Camera: Kowa VX-10α — 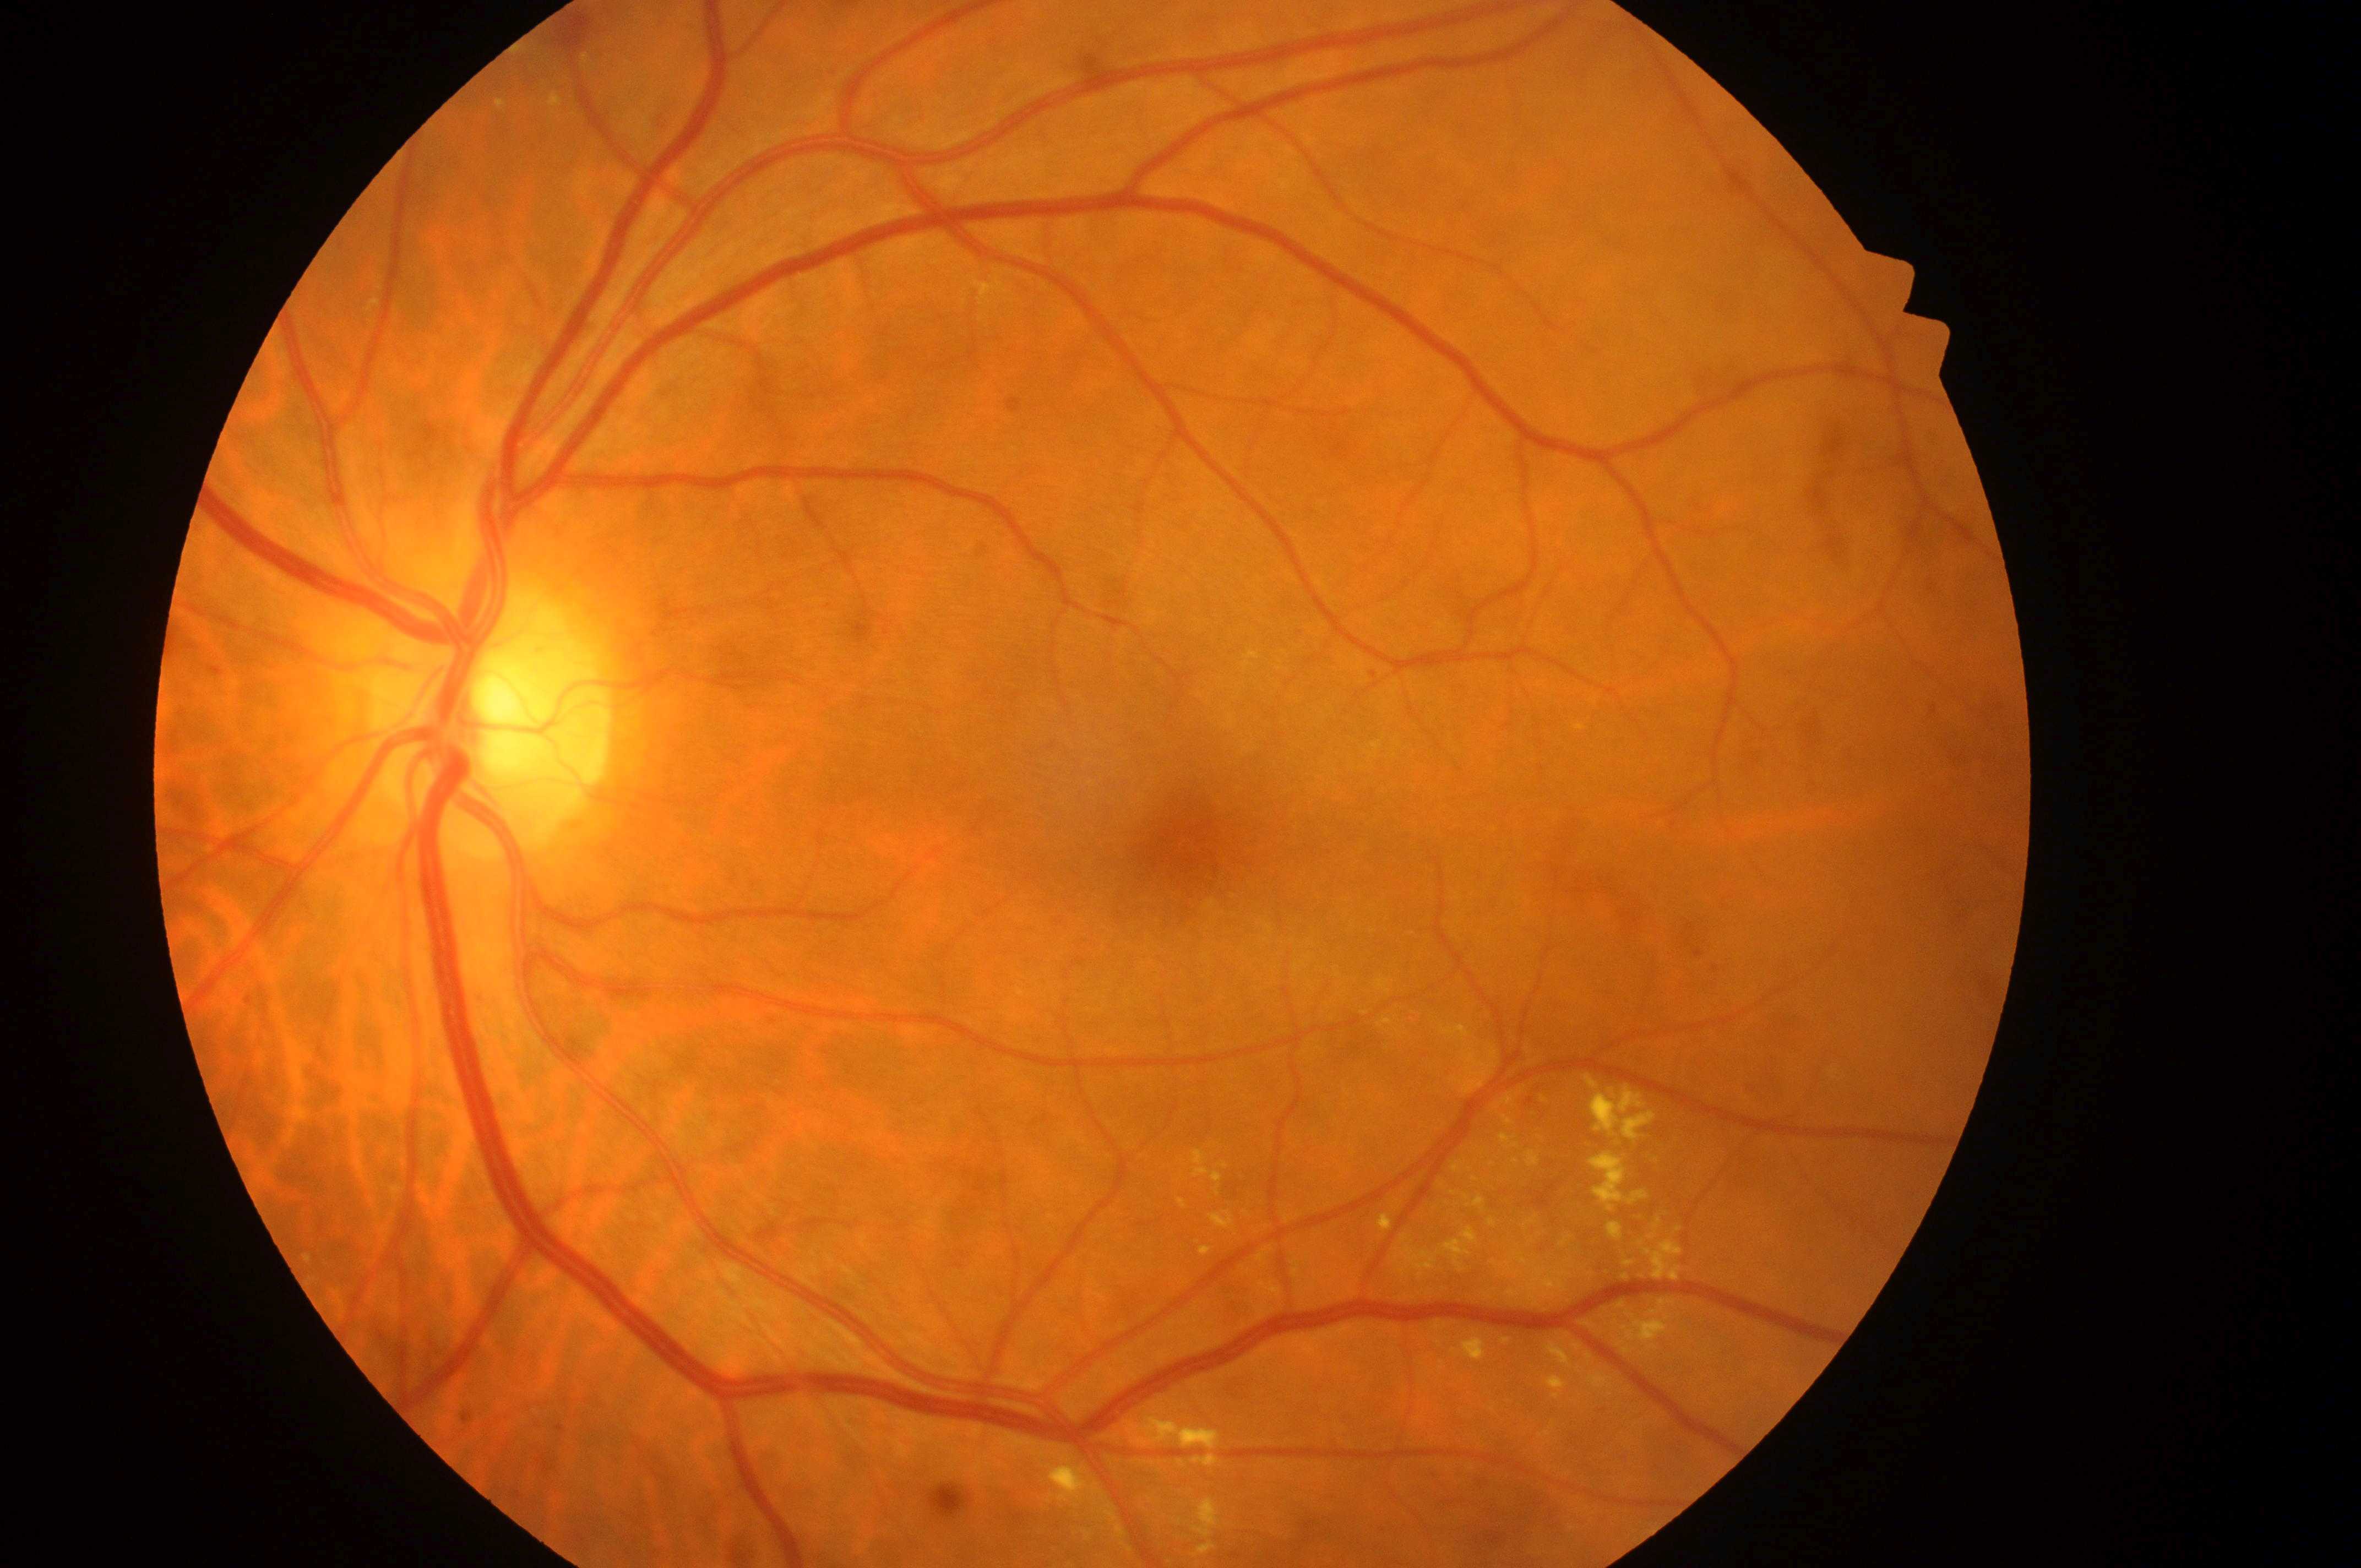
diabetic retinopathy: 2/4; the optic disc: x=491, y=732; foveal center: x=1196, y=839; laterality: left eye; risk of macular edema: 1.